Wide-field fundus photograph of an infant. Acquired on the Natus RetCam Envision: 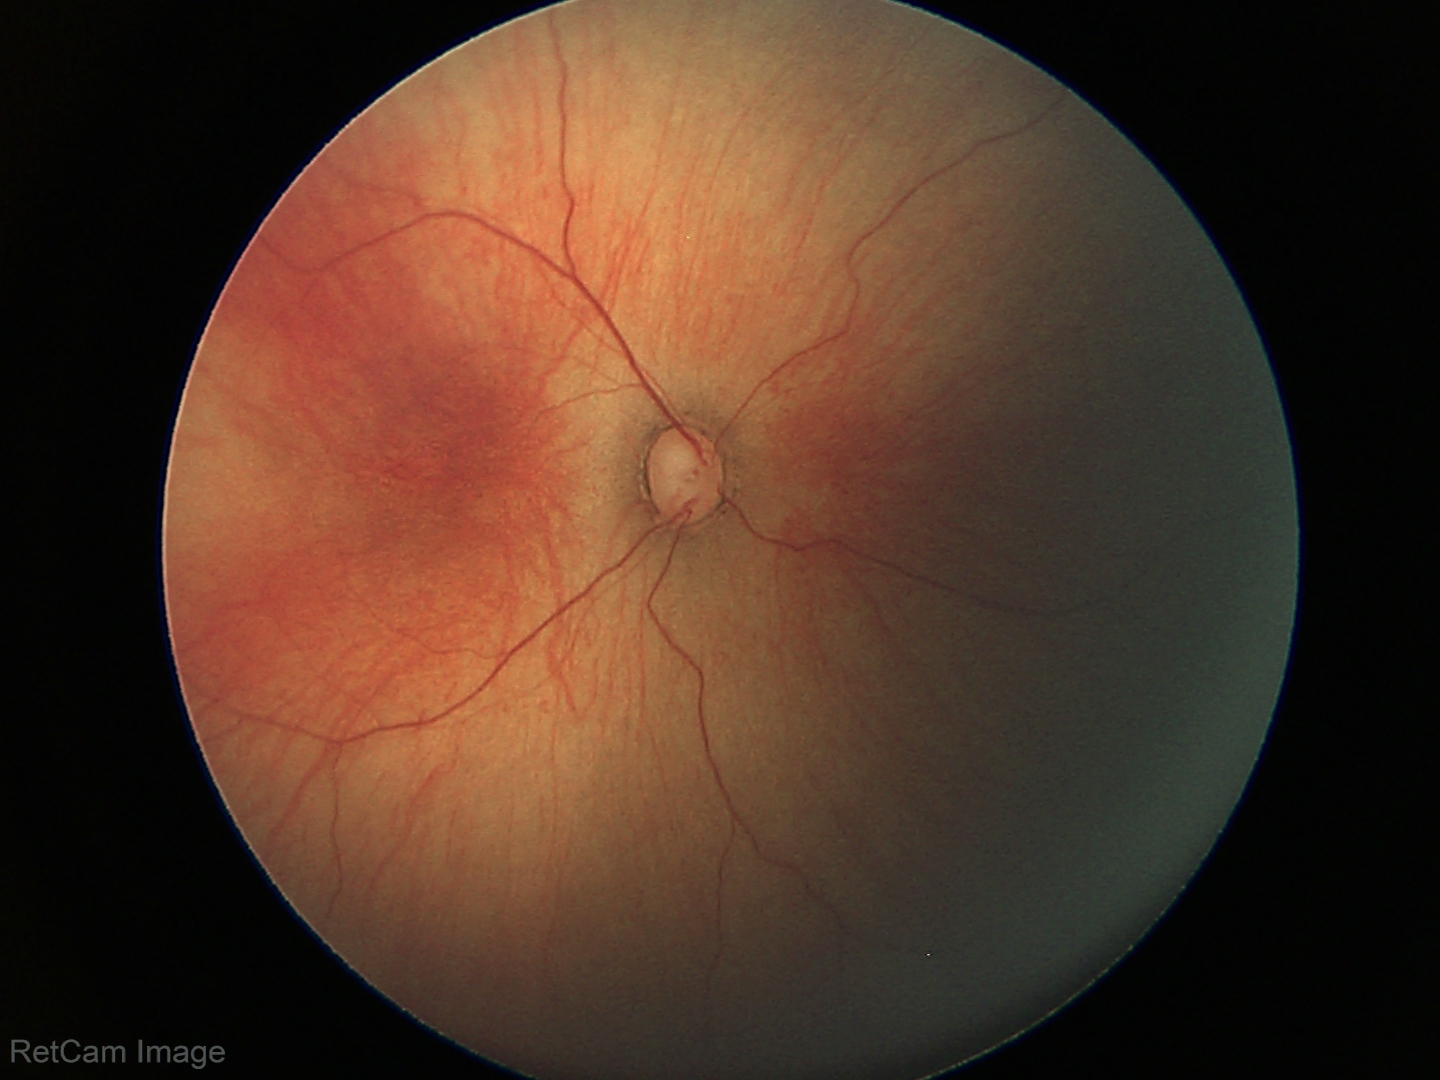

Impression = physiological appearance.